Wide-field contact fundus photograph of an infant:
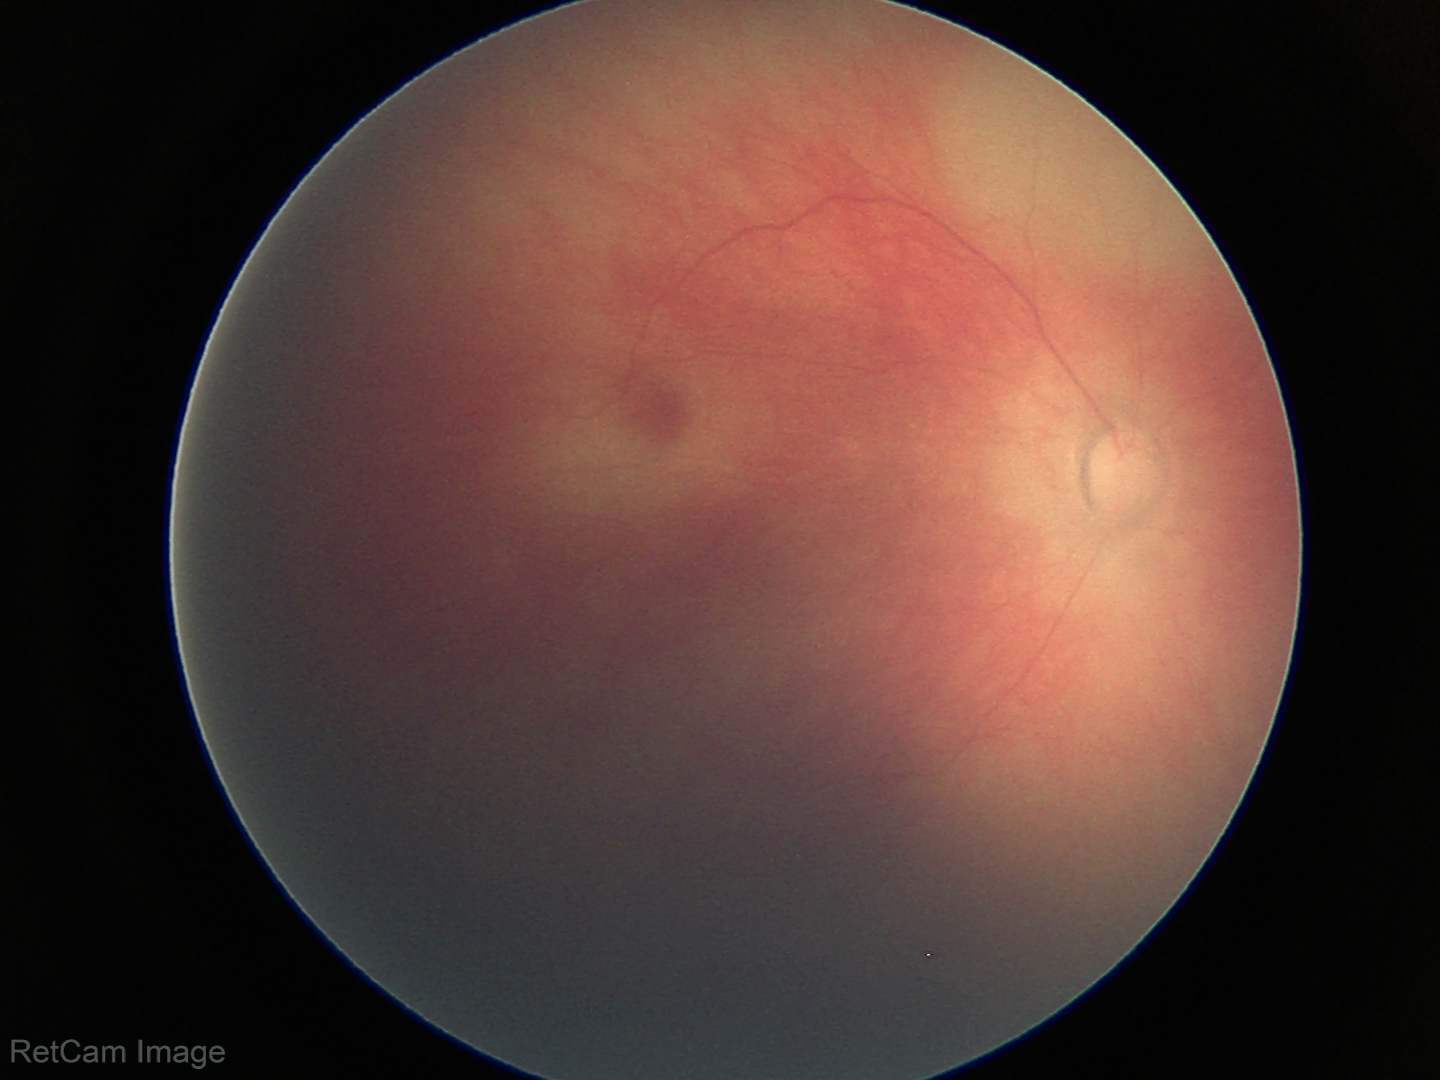 Screening examination diagnosed as physiological.